848 x 848 pixels. NIDEK AFC-230:
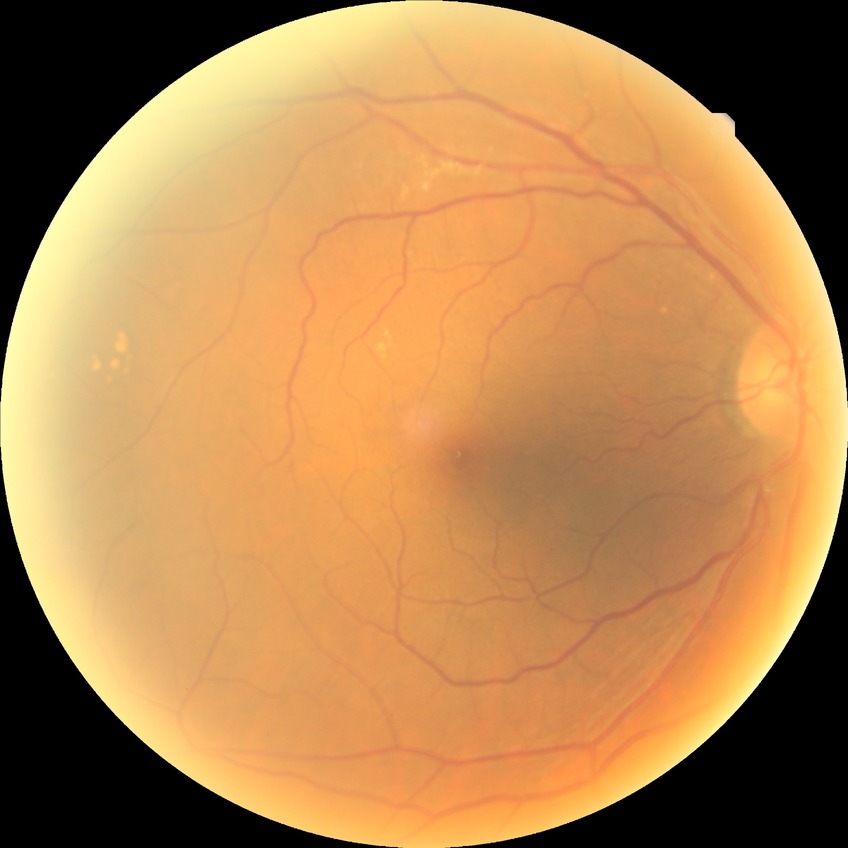
Modified Davis grade is NDR.